1659x2212, fundus photo, camera: Remidio Fundus on Phone (FOP) camera
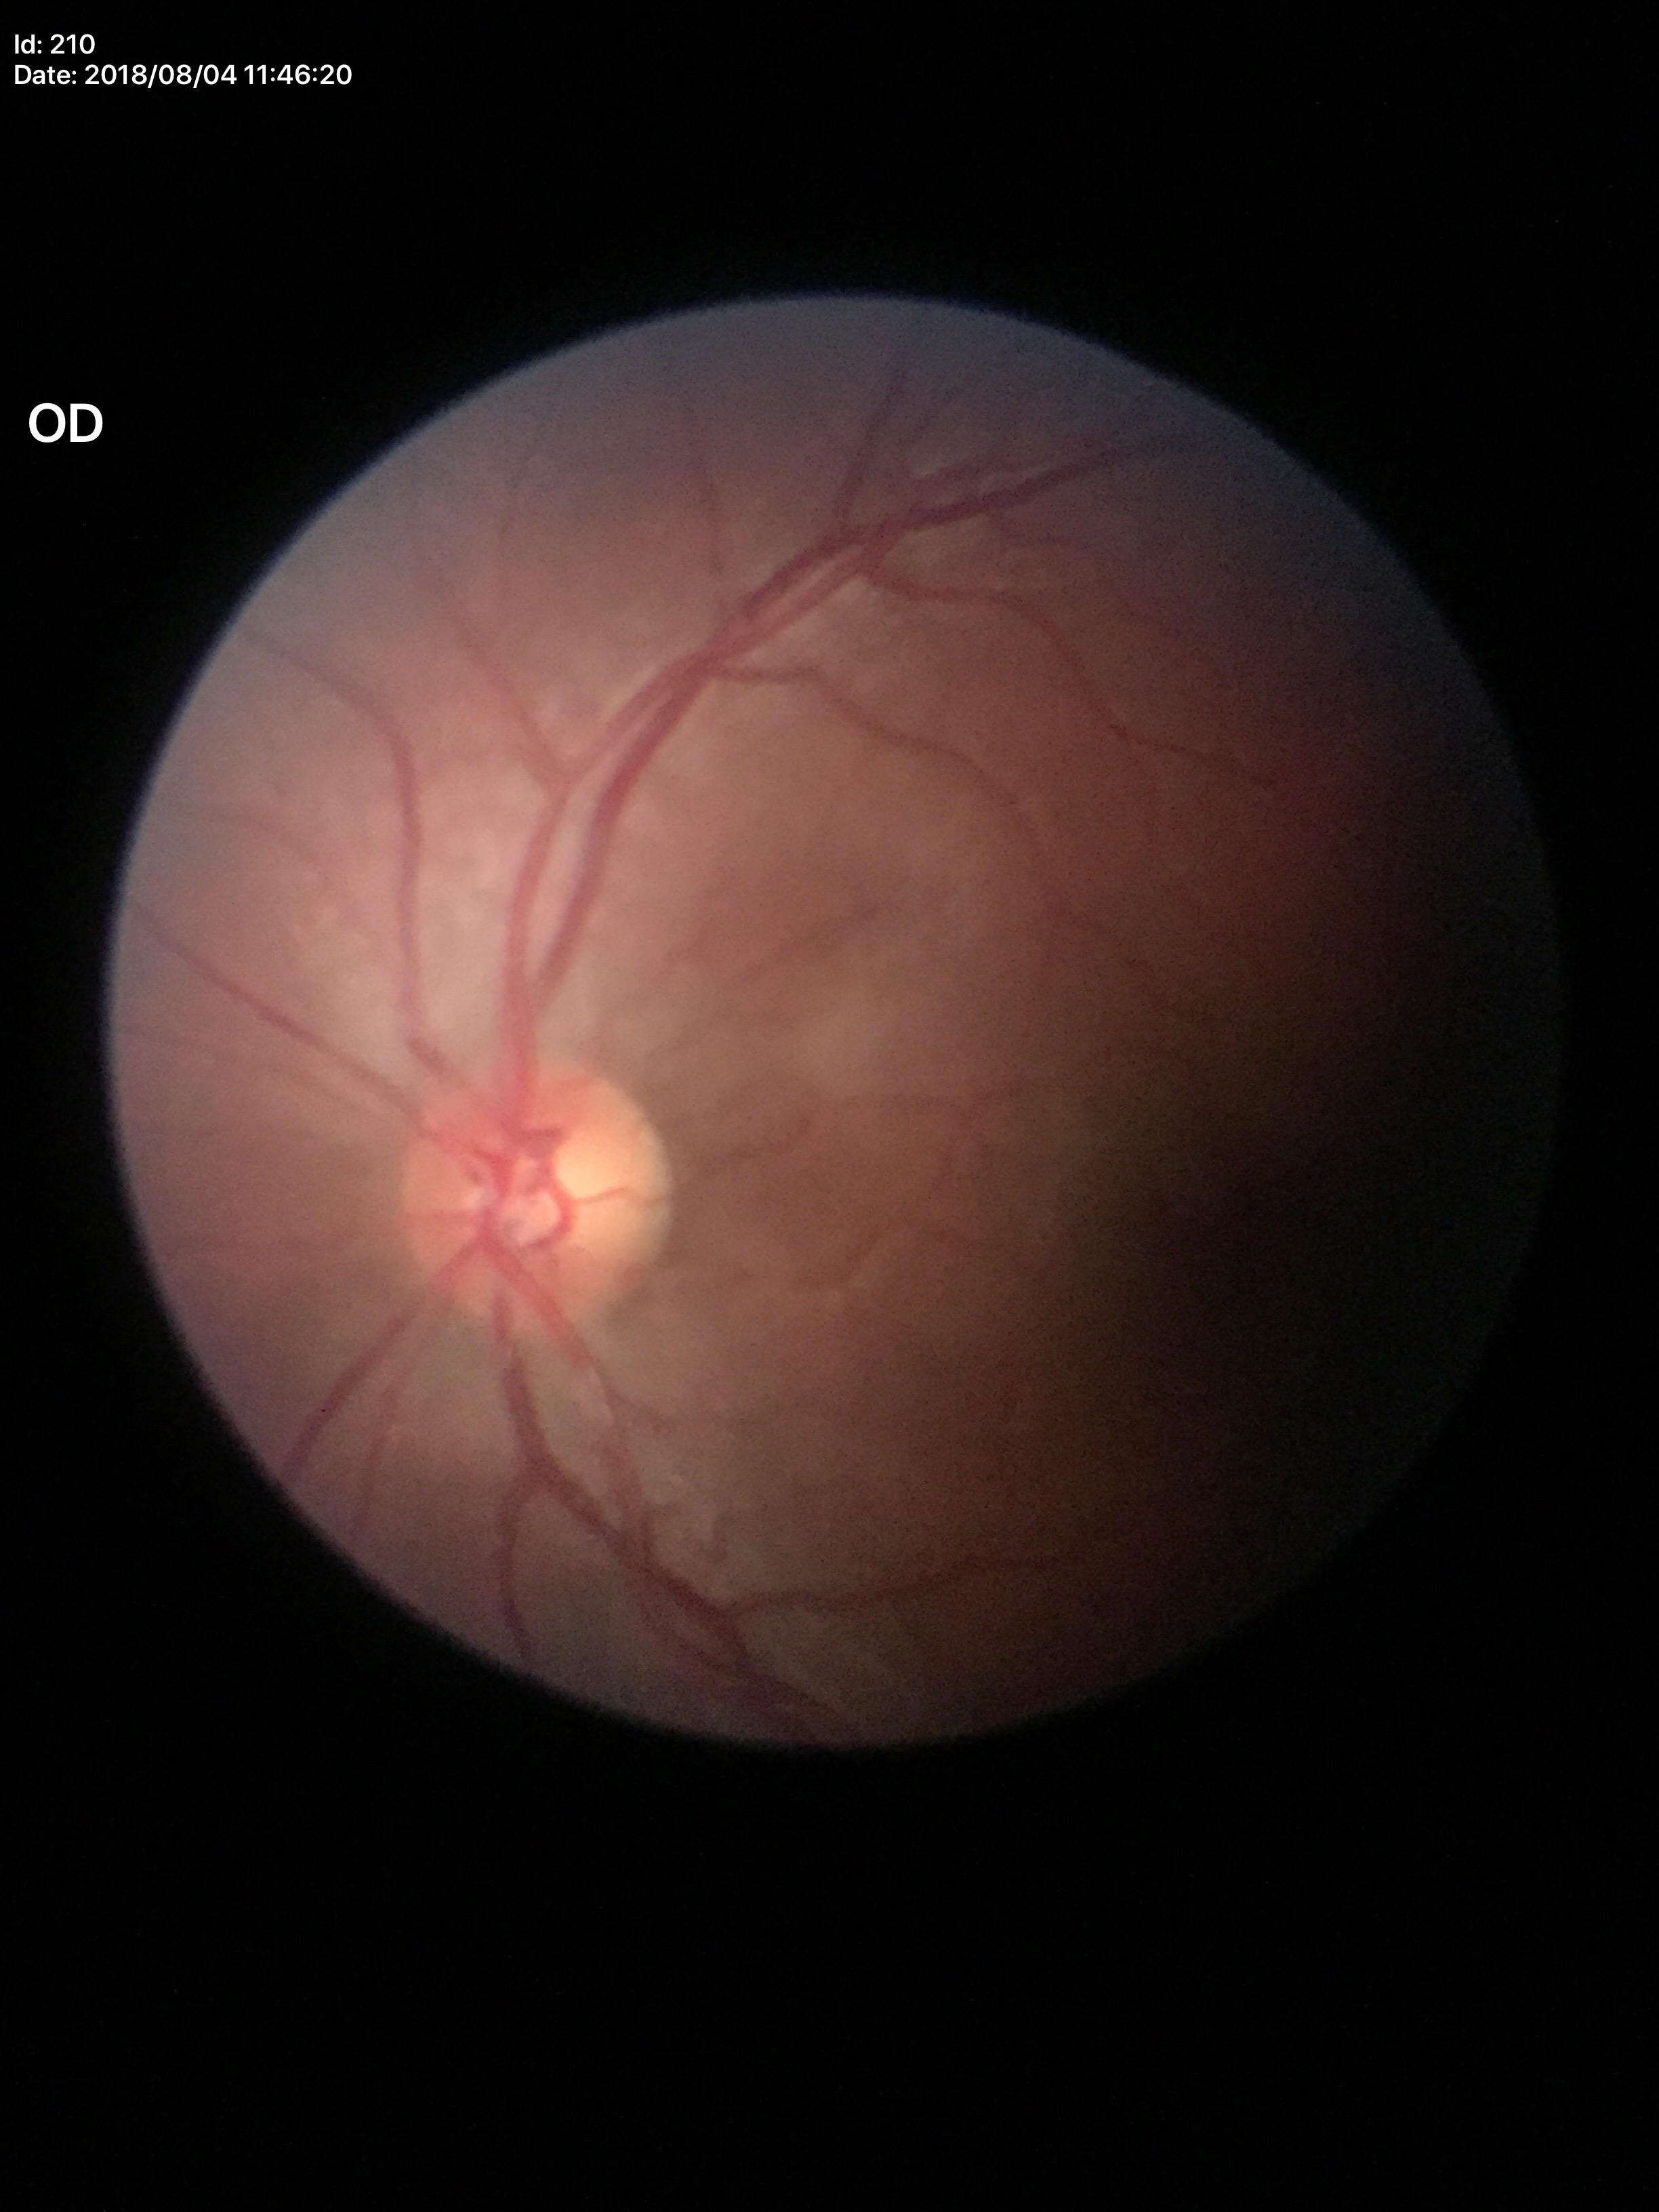
Area cup-disc ratio (ACDR) of 0.30. Horizontal cup-to-disc ratio (HCDR): 0.59. Vertical cup-to-disc ratio (VCDR) of 0.50. Glaucoma screening impression: negative.